2048x1536
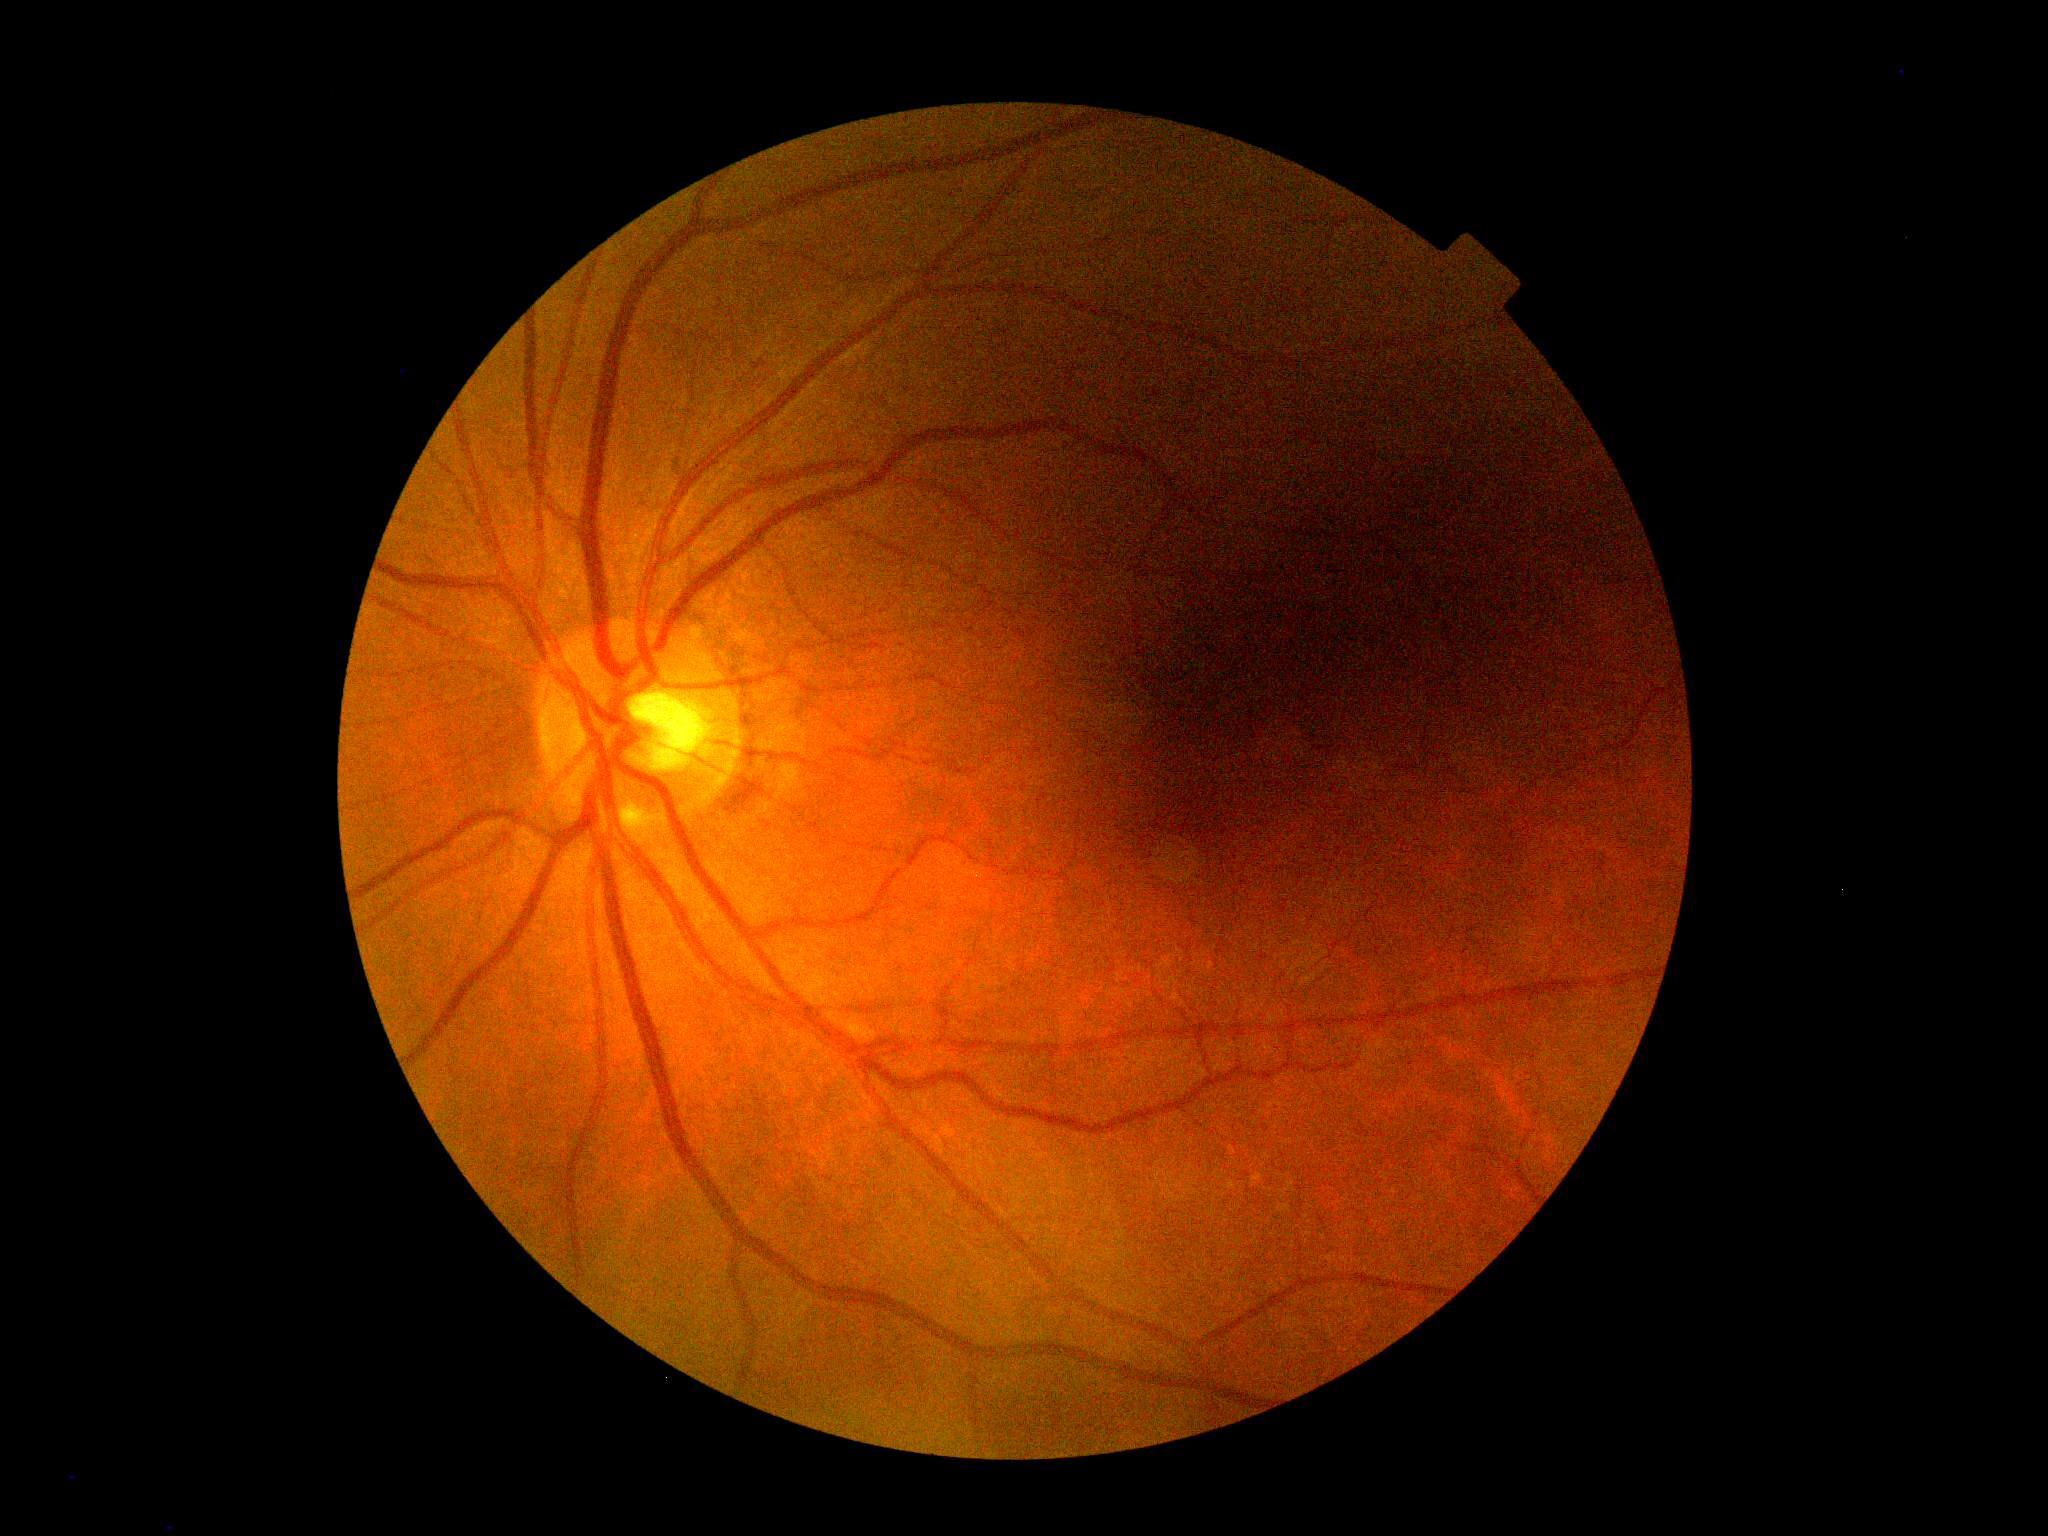
Findings:
– retinopathy grade: 0 (no apparent retinopathy)